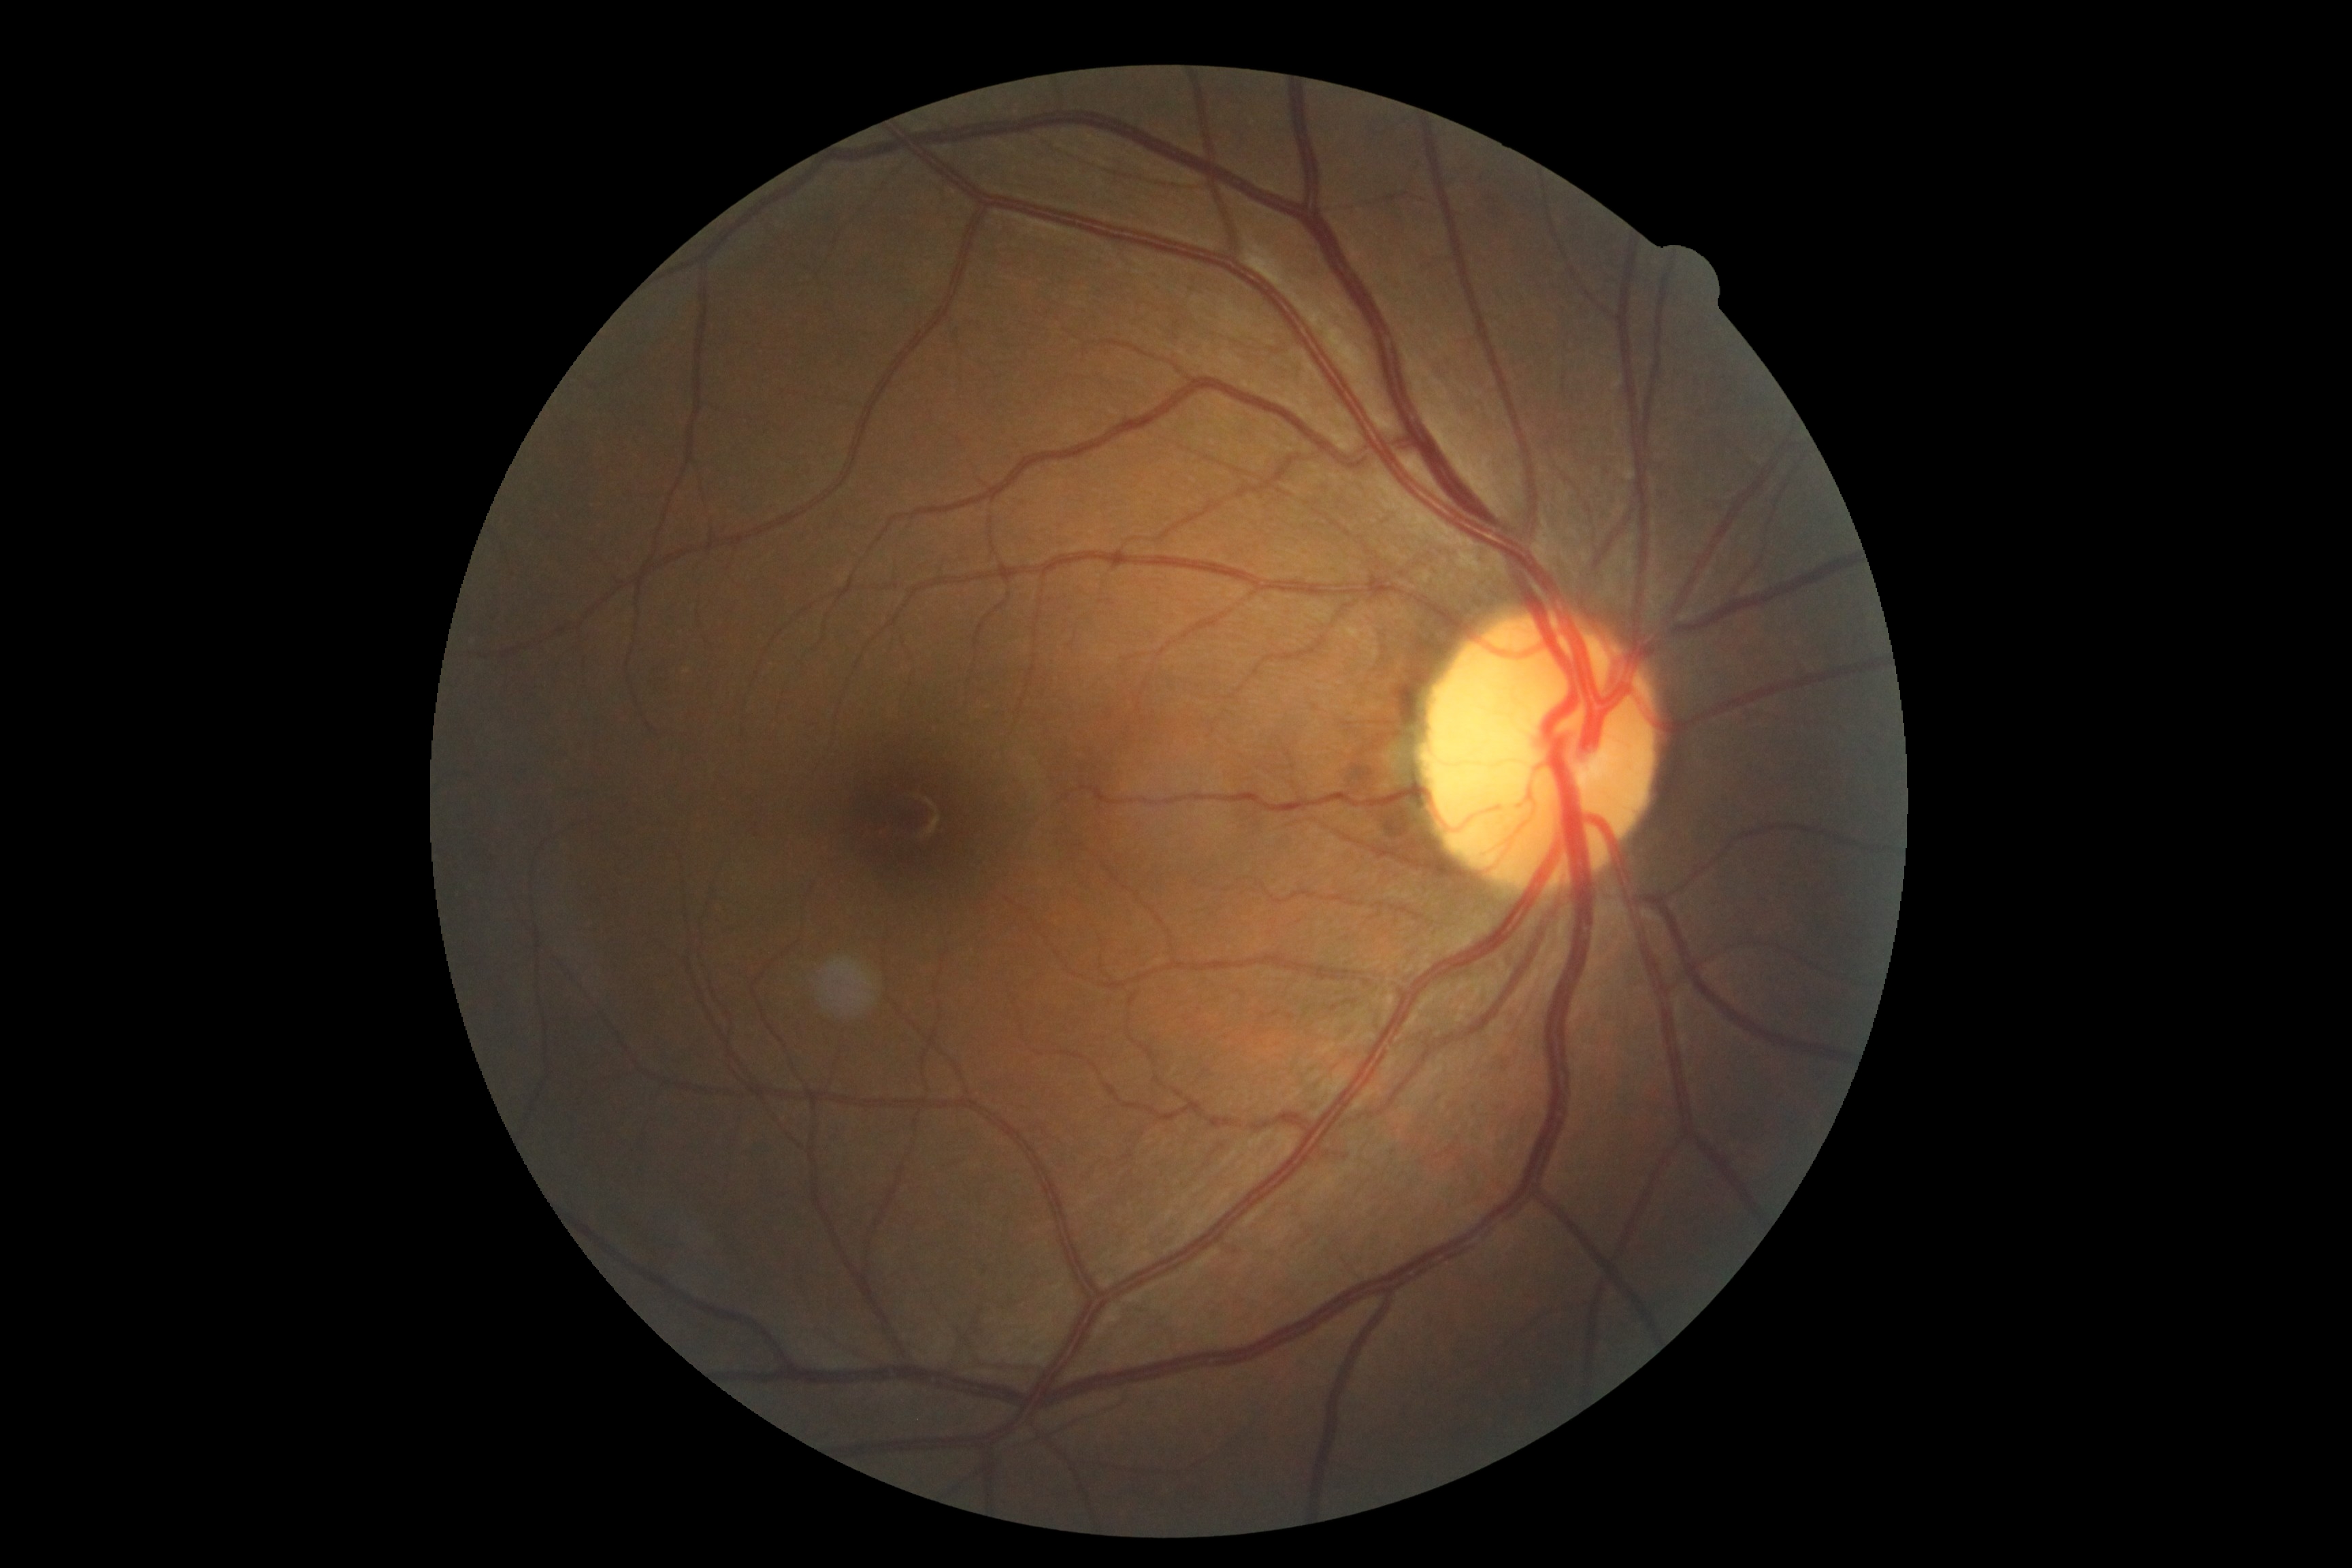

diabetic retinopathy (DR)=grade 0 (no apparent retinopathy); DR impression=negative for DR.